Infant wide-field retinal image; 1440 by 1080 pixels: 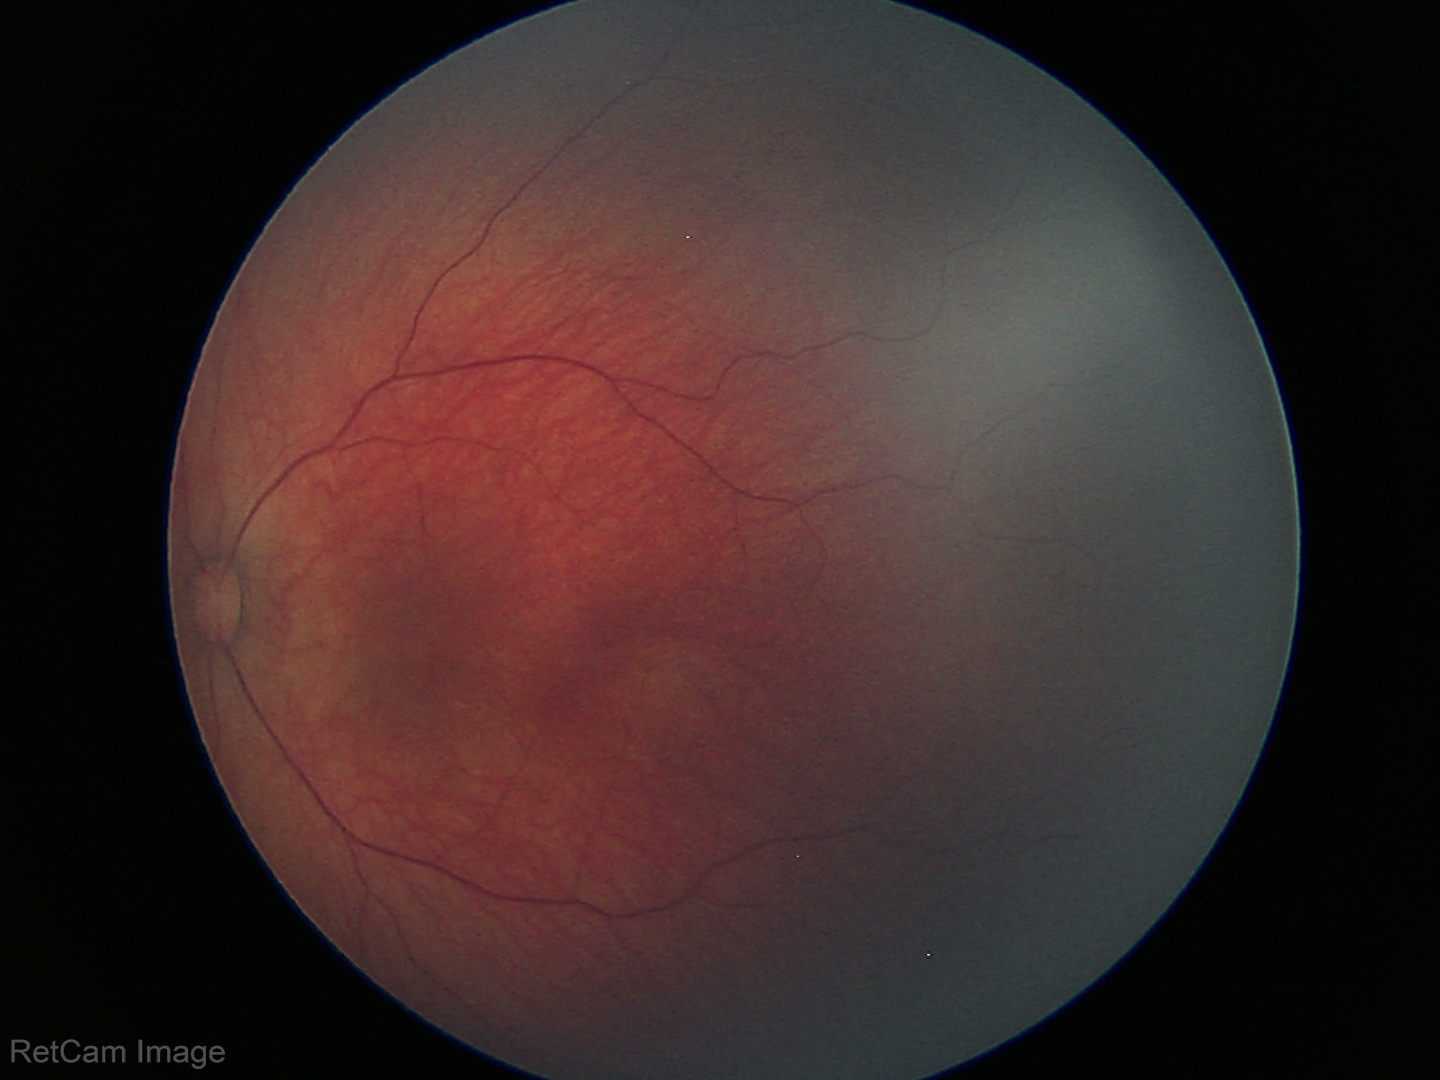

Q: What is the diagnosis from this examination?
A: retinal hemorrhages